45° field of view. 2352 x 1568 pixels
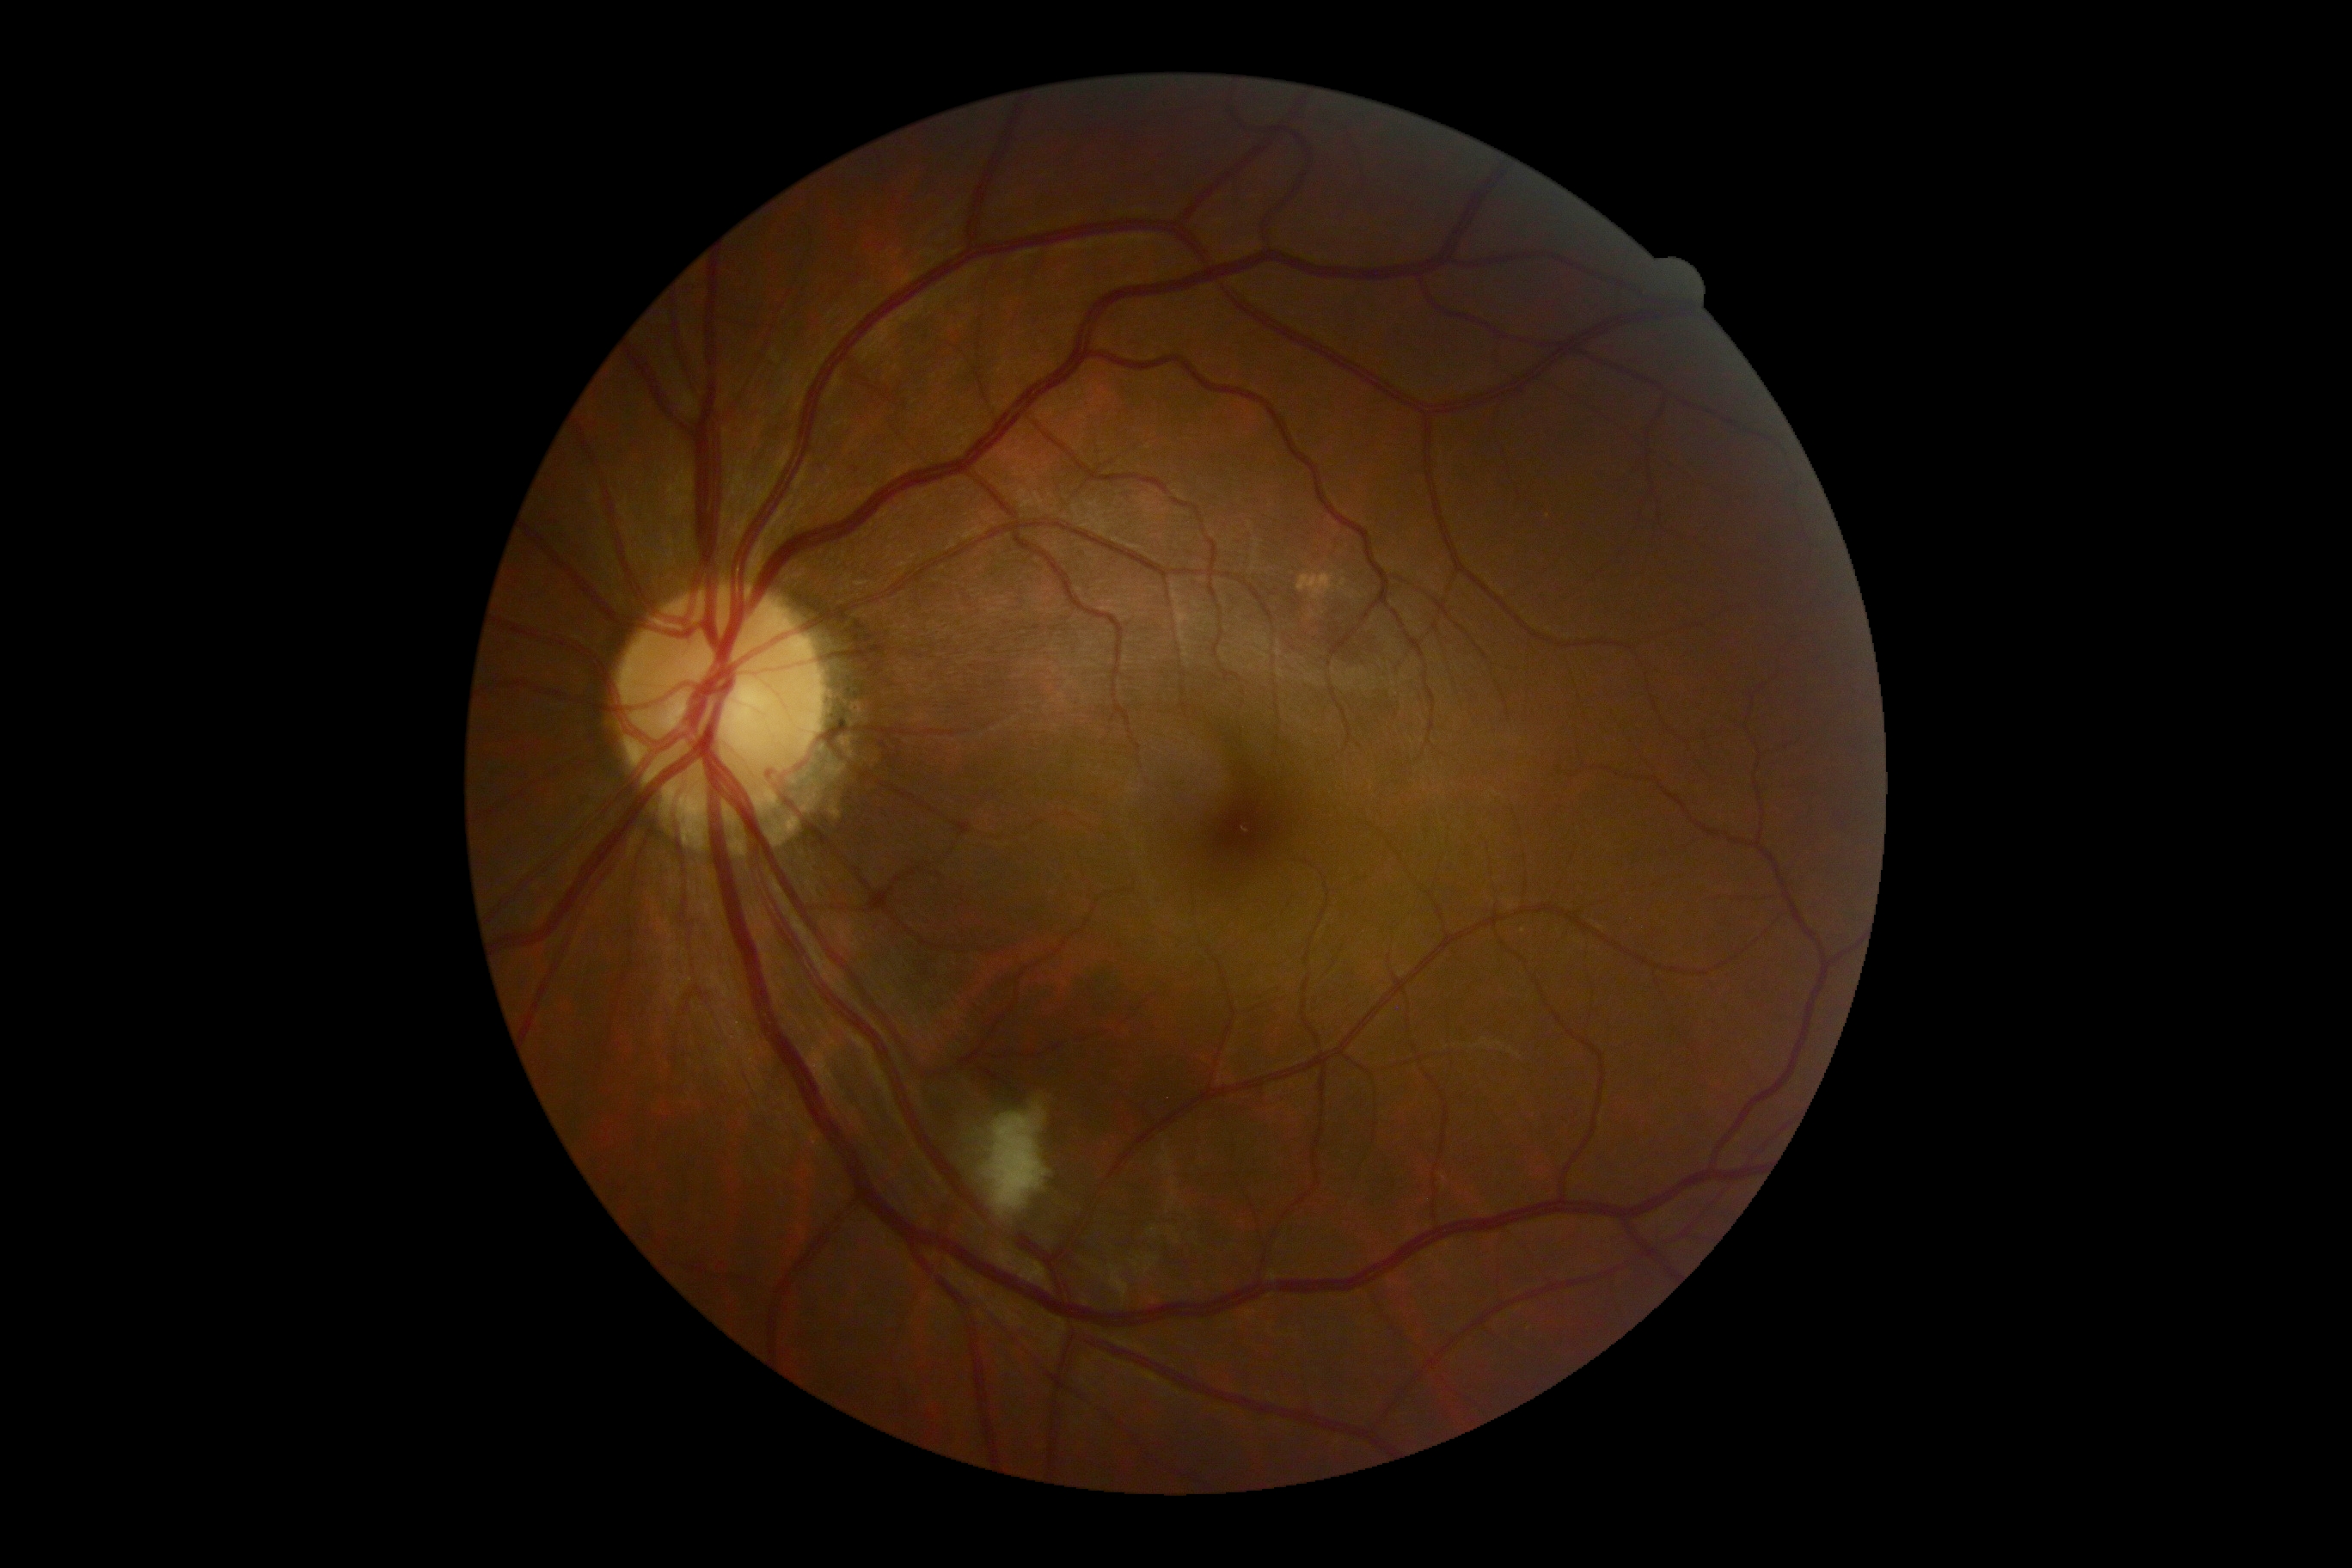
DR grade is 2.